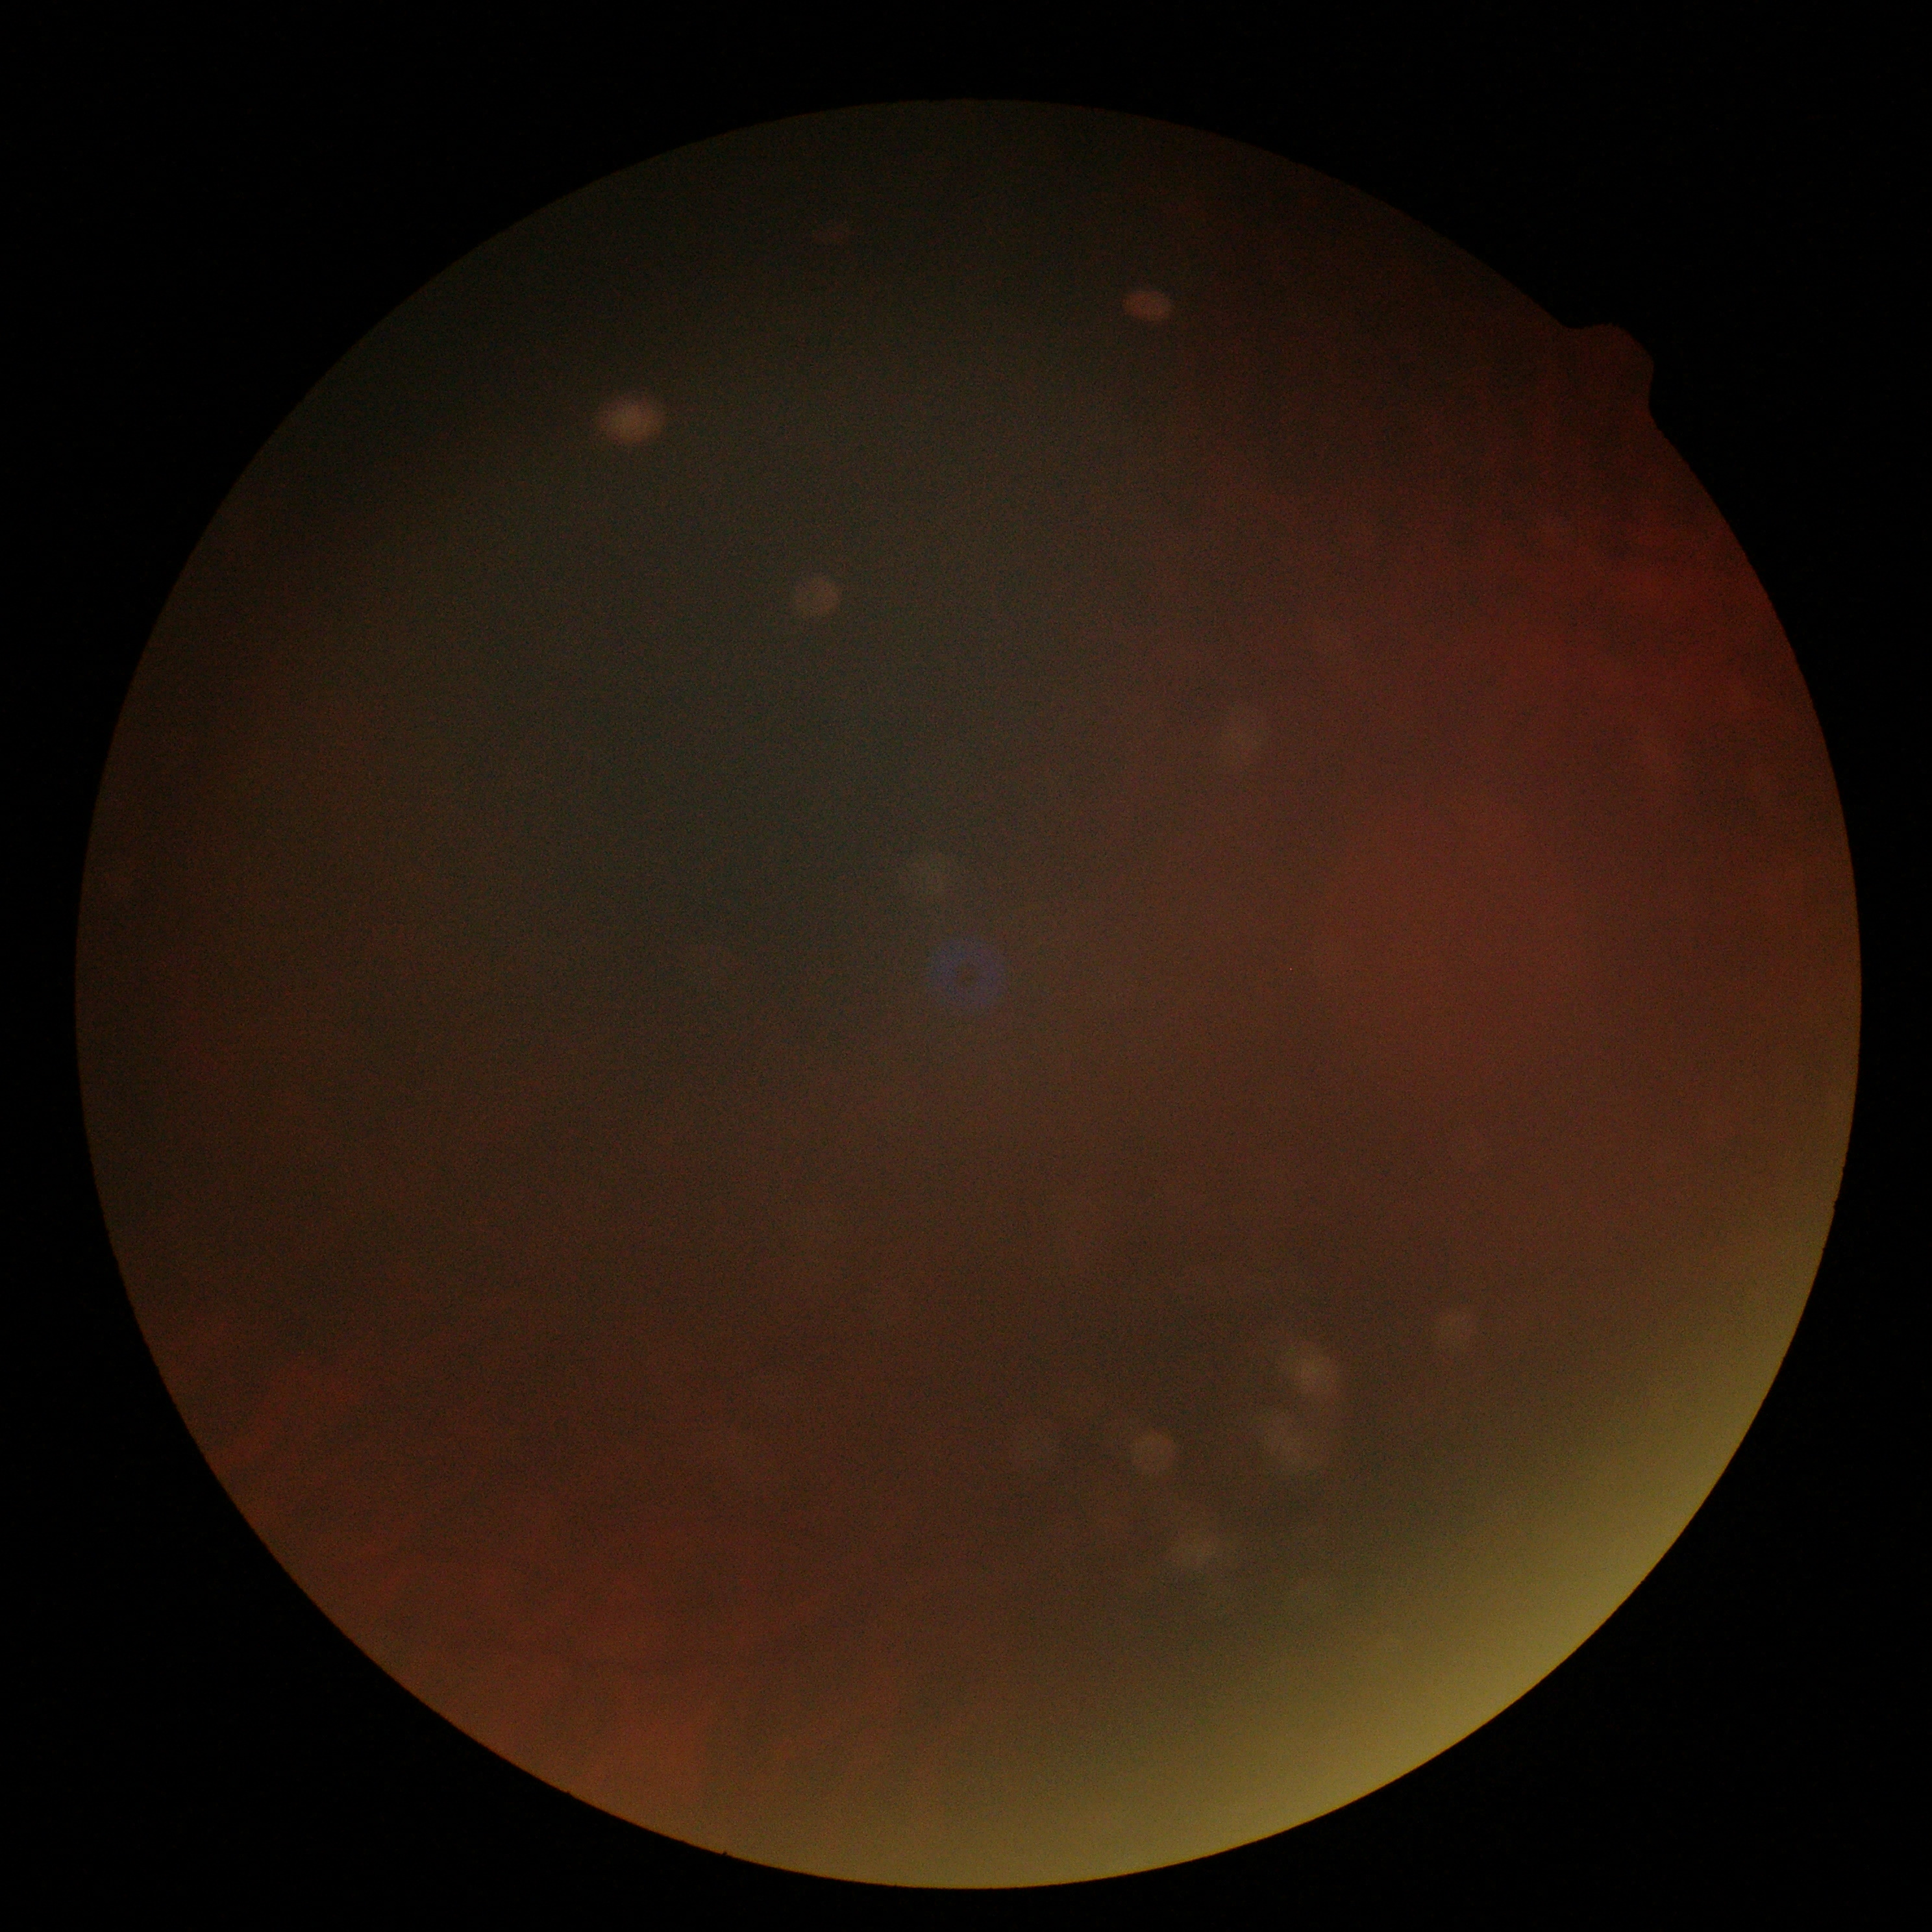
DR: ungradable.